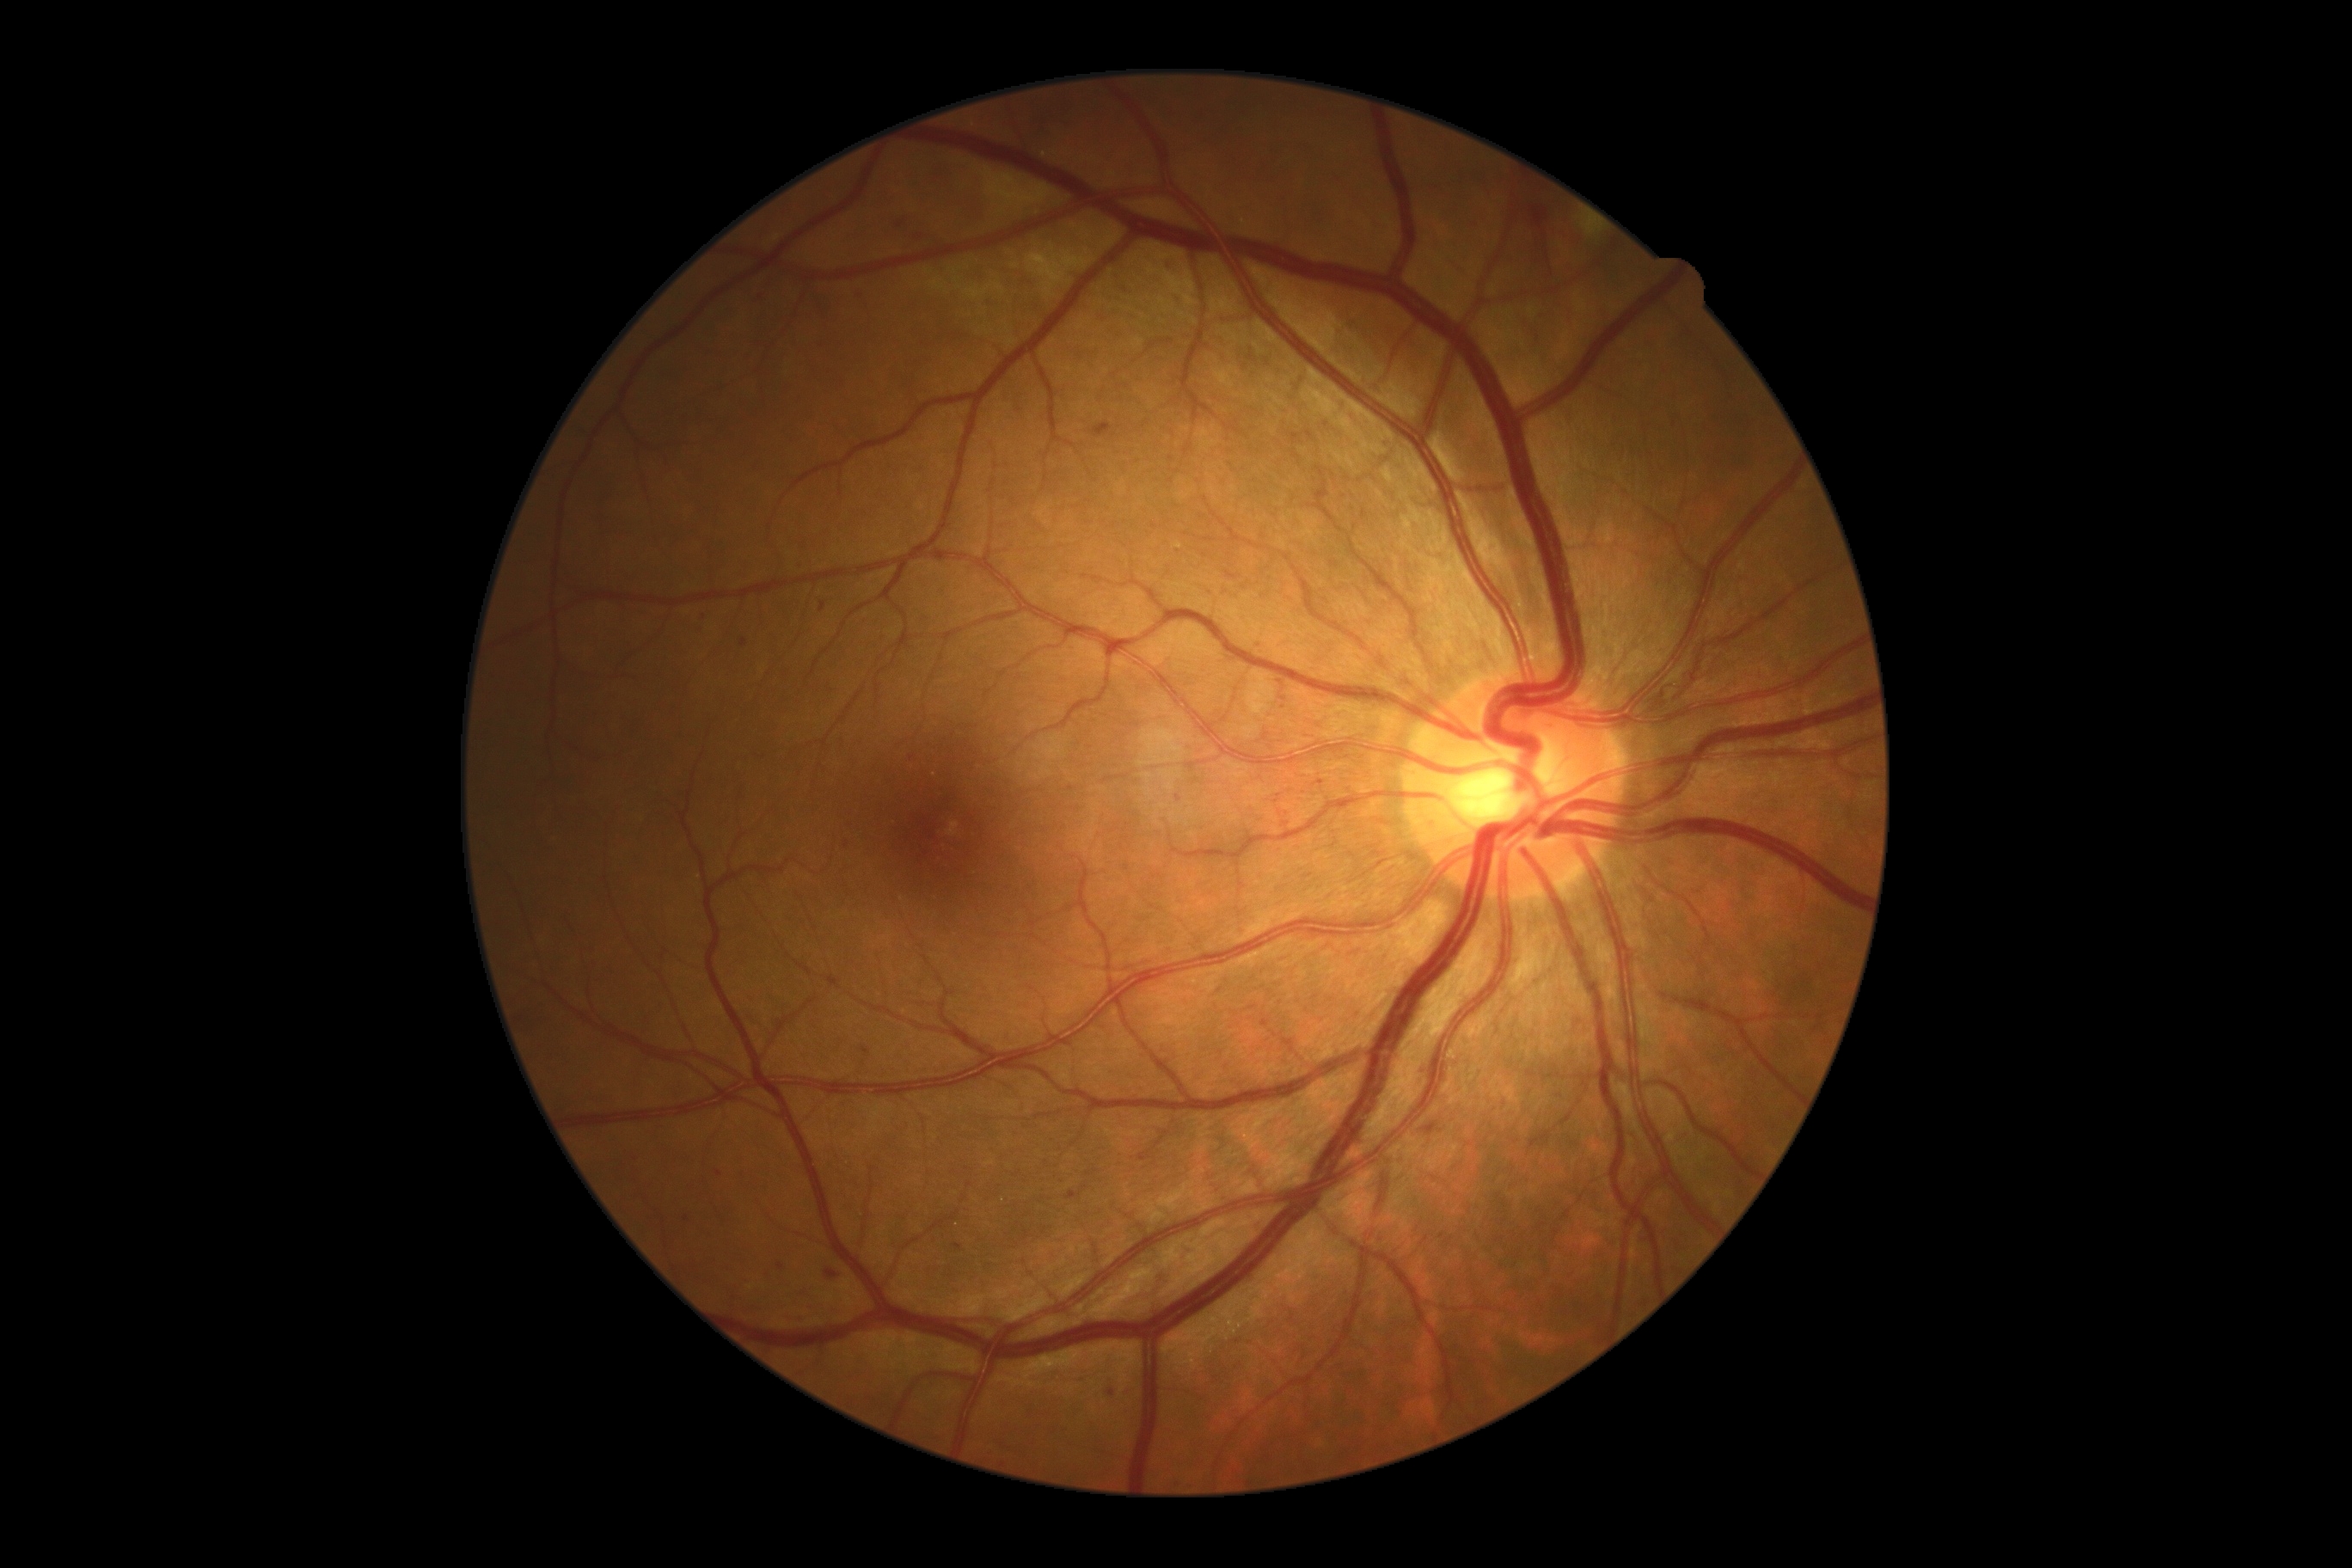 diabetic retinopathy grade: moderate non-proliferative diabetic retinopathy (2).